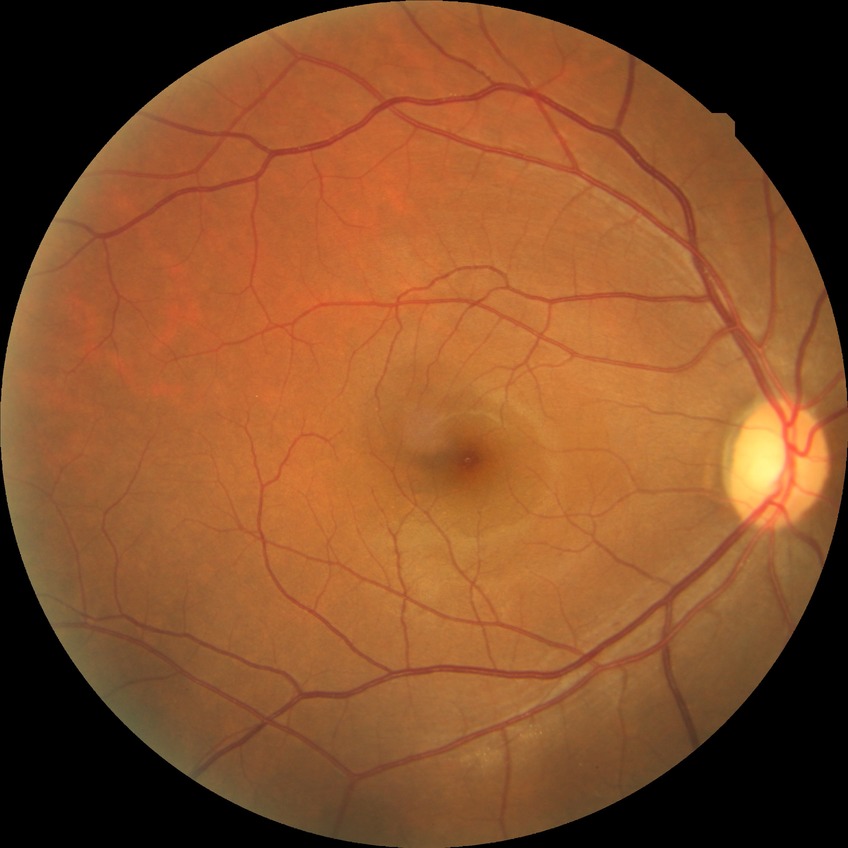

Diabetic retinopathy (DR) is NDR (no diabetic retinopathy).